Fundus photo: 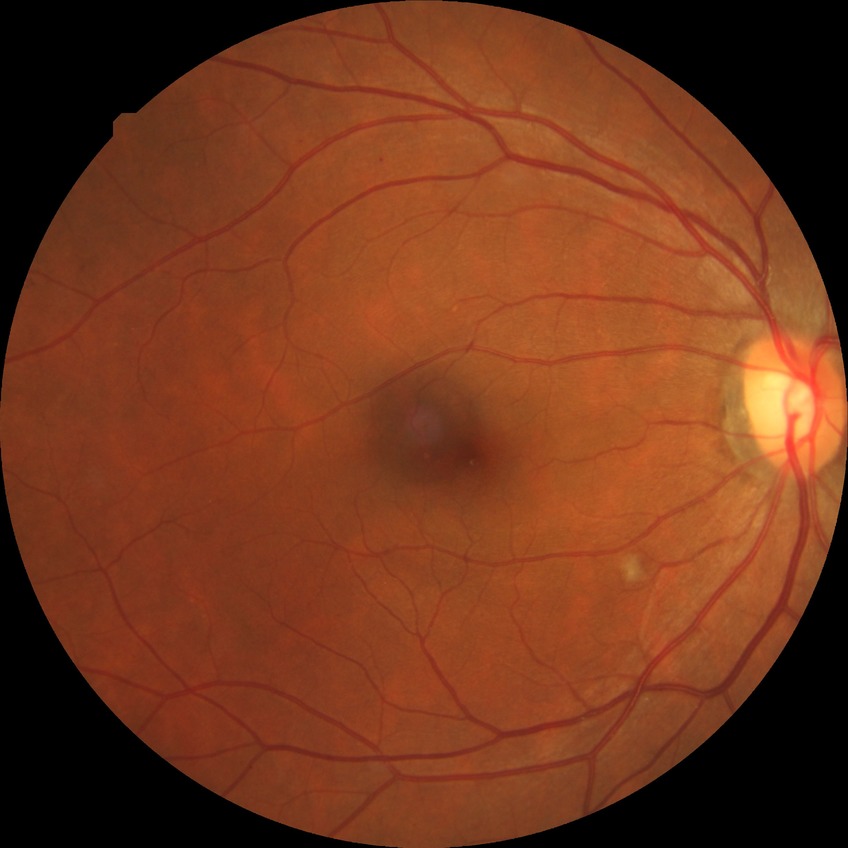 diabetic retinopathy (DR) = SDR (simple diabetic retinopathy).